Nonmydriatic; 848 x 848 pixels
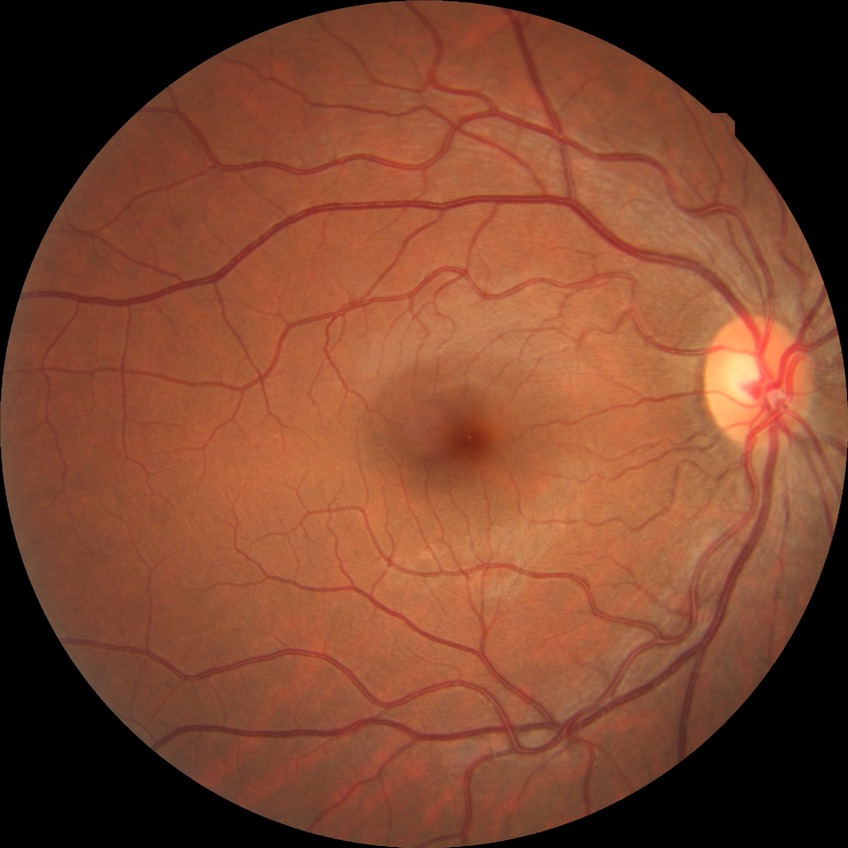
Diabetic retinopathy (DR): NDR (no diabetic retinopathy).